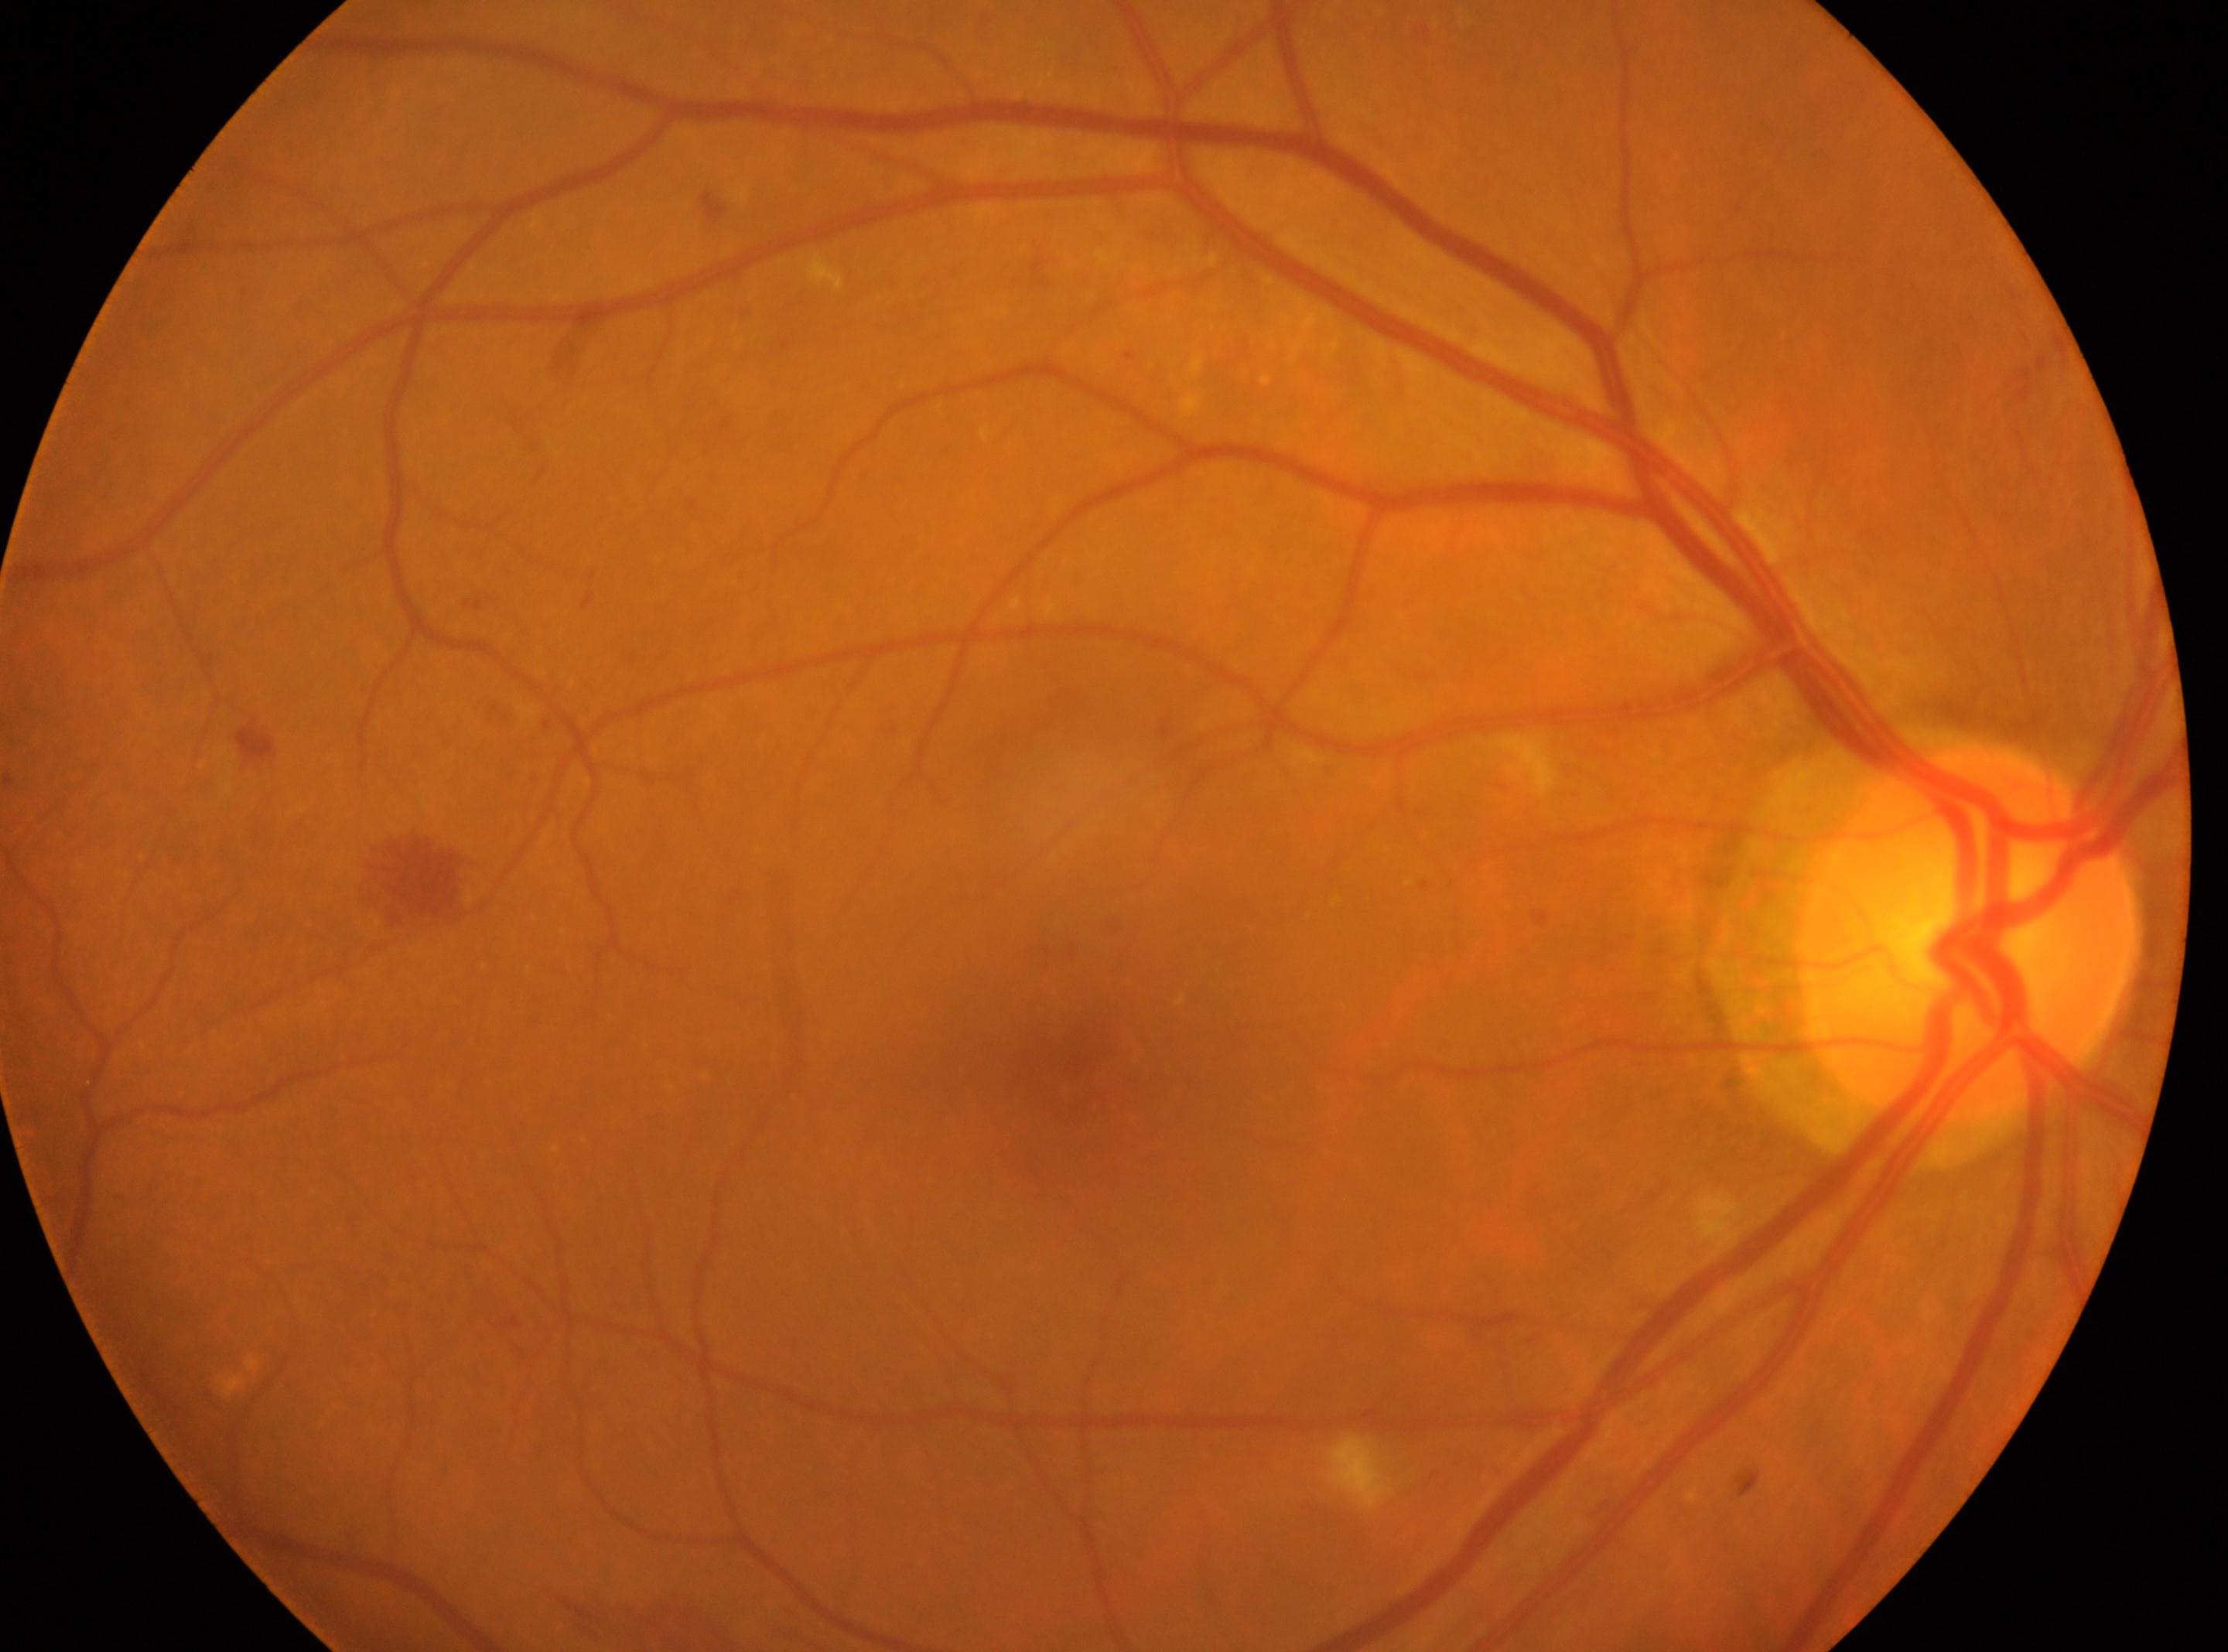 Disc center: (1967, 934).
This is the OD.
Diabetic retinopathy severity: grade 2 (moderate NPDR).
Macular center: (1100, 1073).